FOV: 45 degrees. Fundus photo. Image size 2352x1568 — 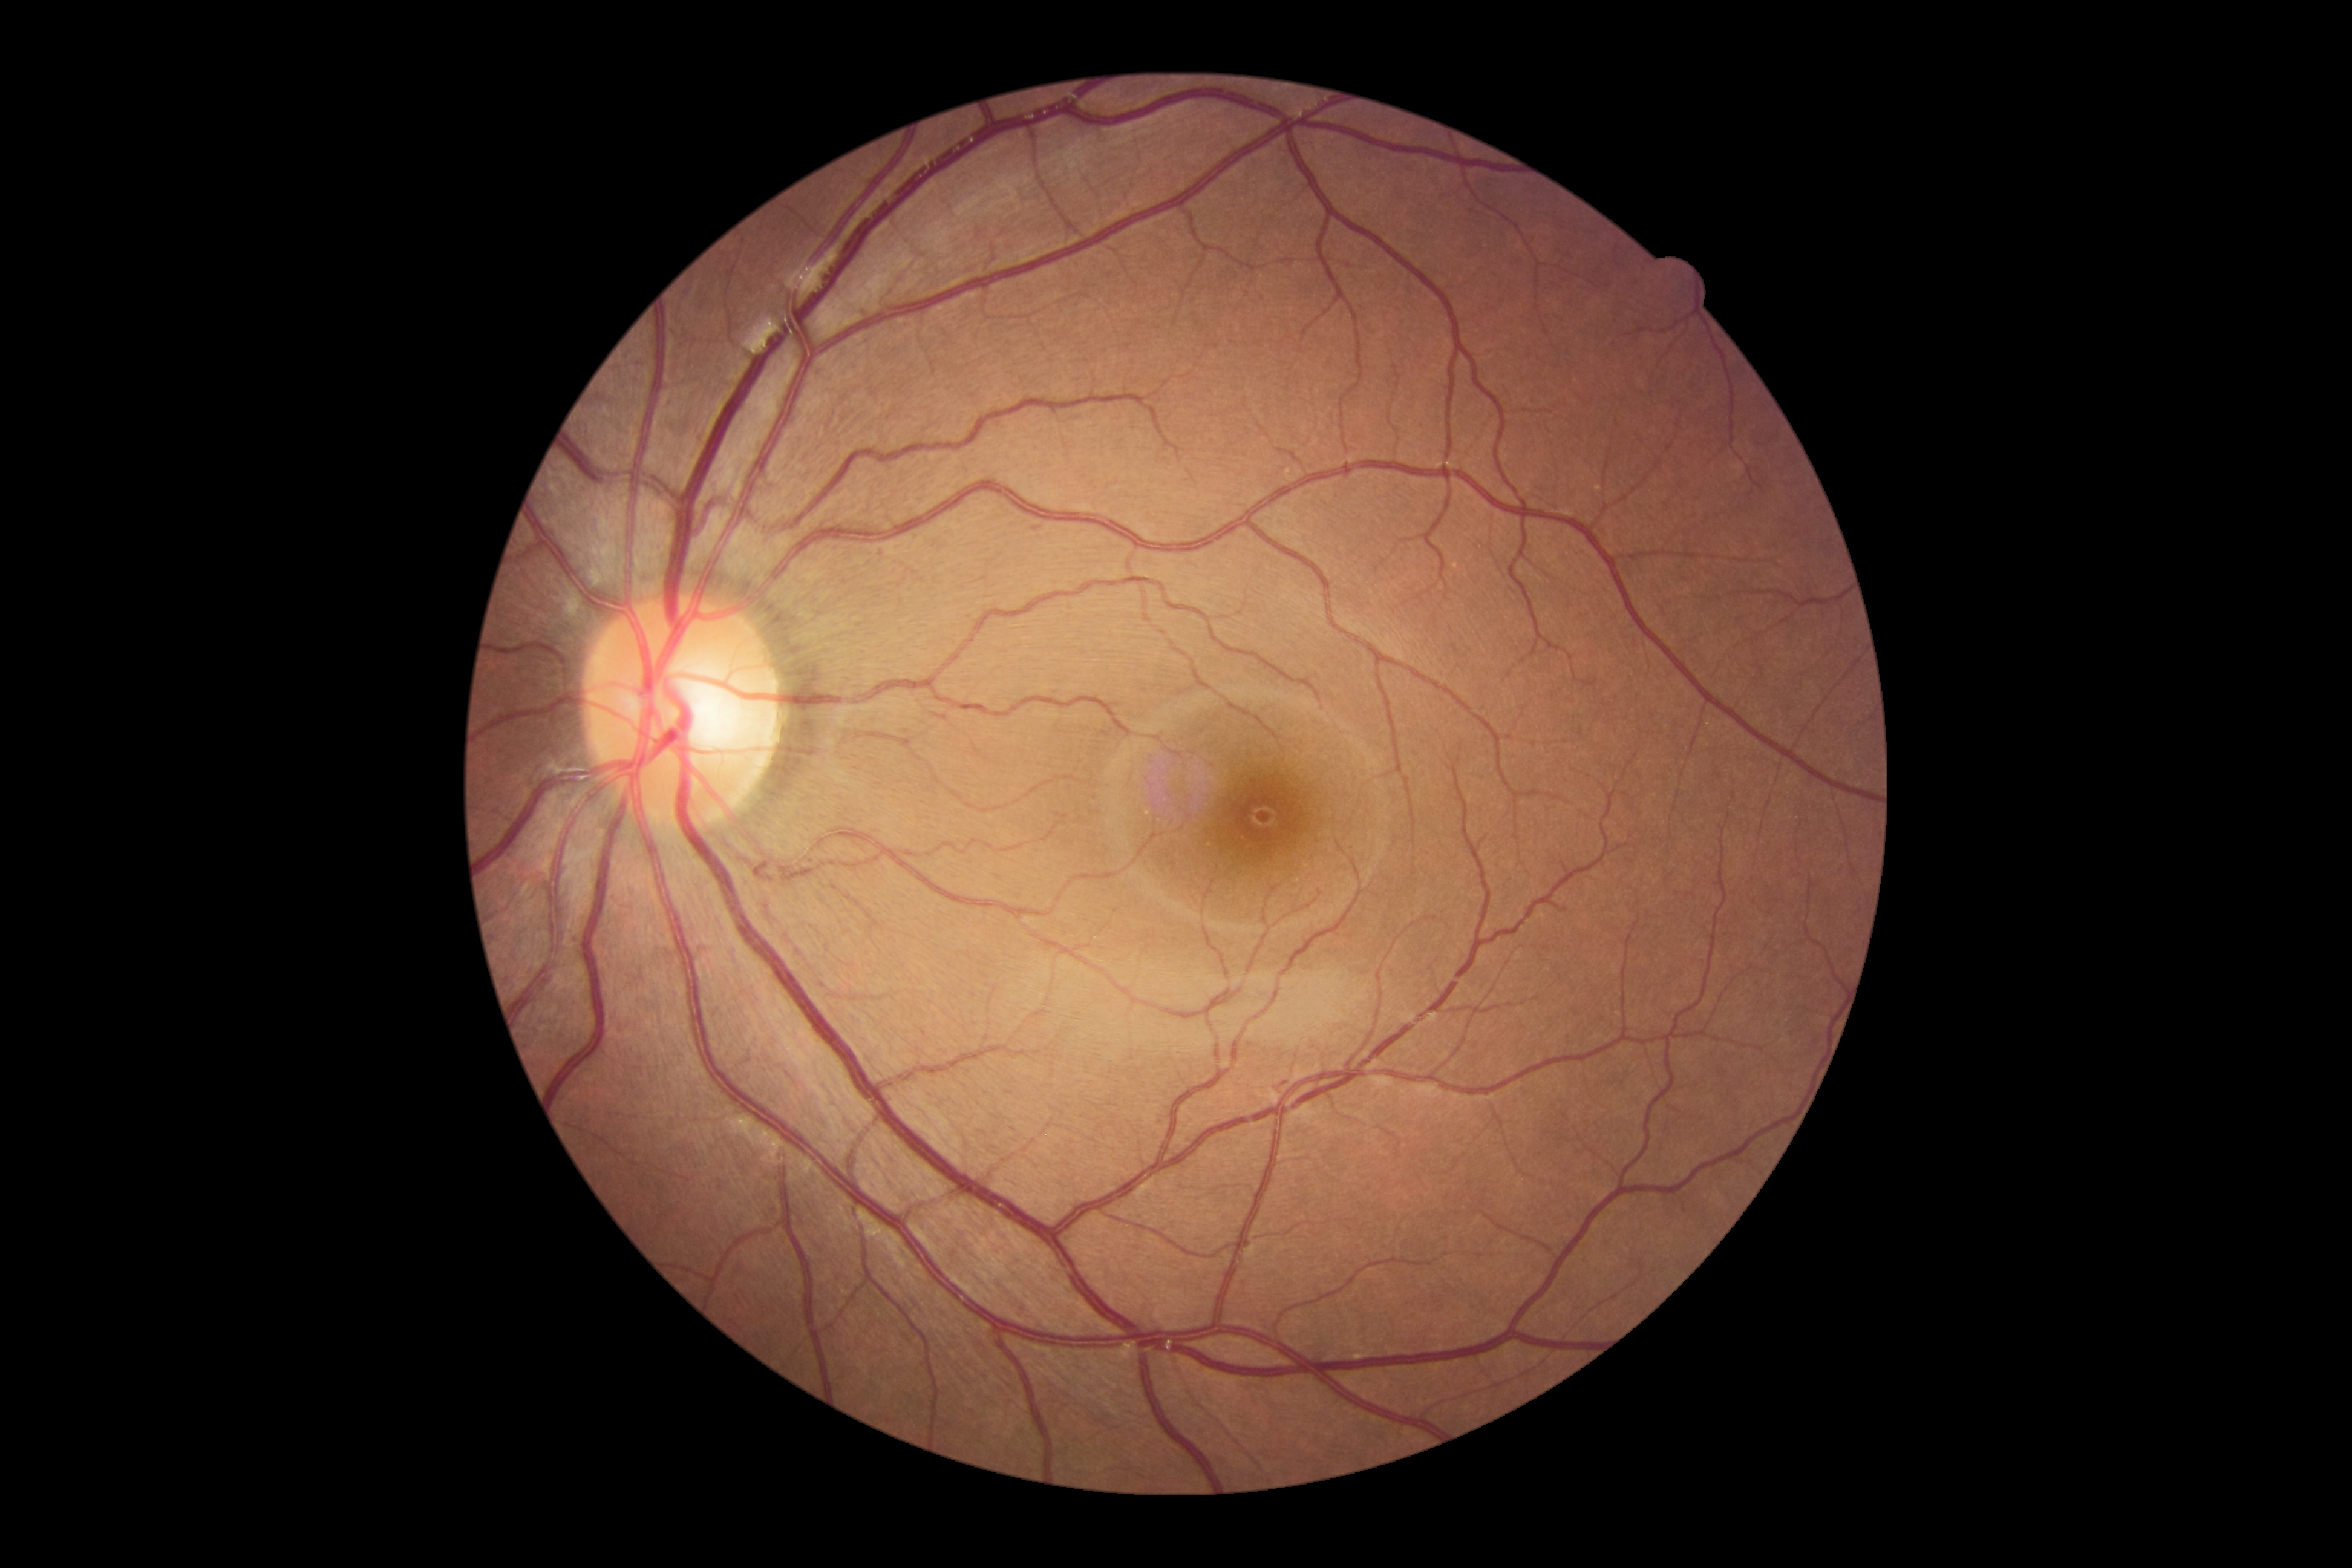

Diabetic retinopathy (DR) is grade 0 (no apparent retinopathy). No diabetic retinal disease findings.